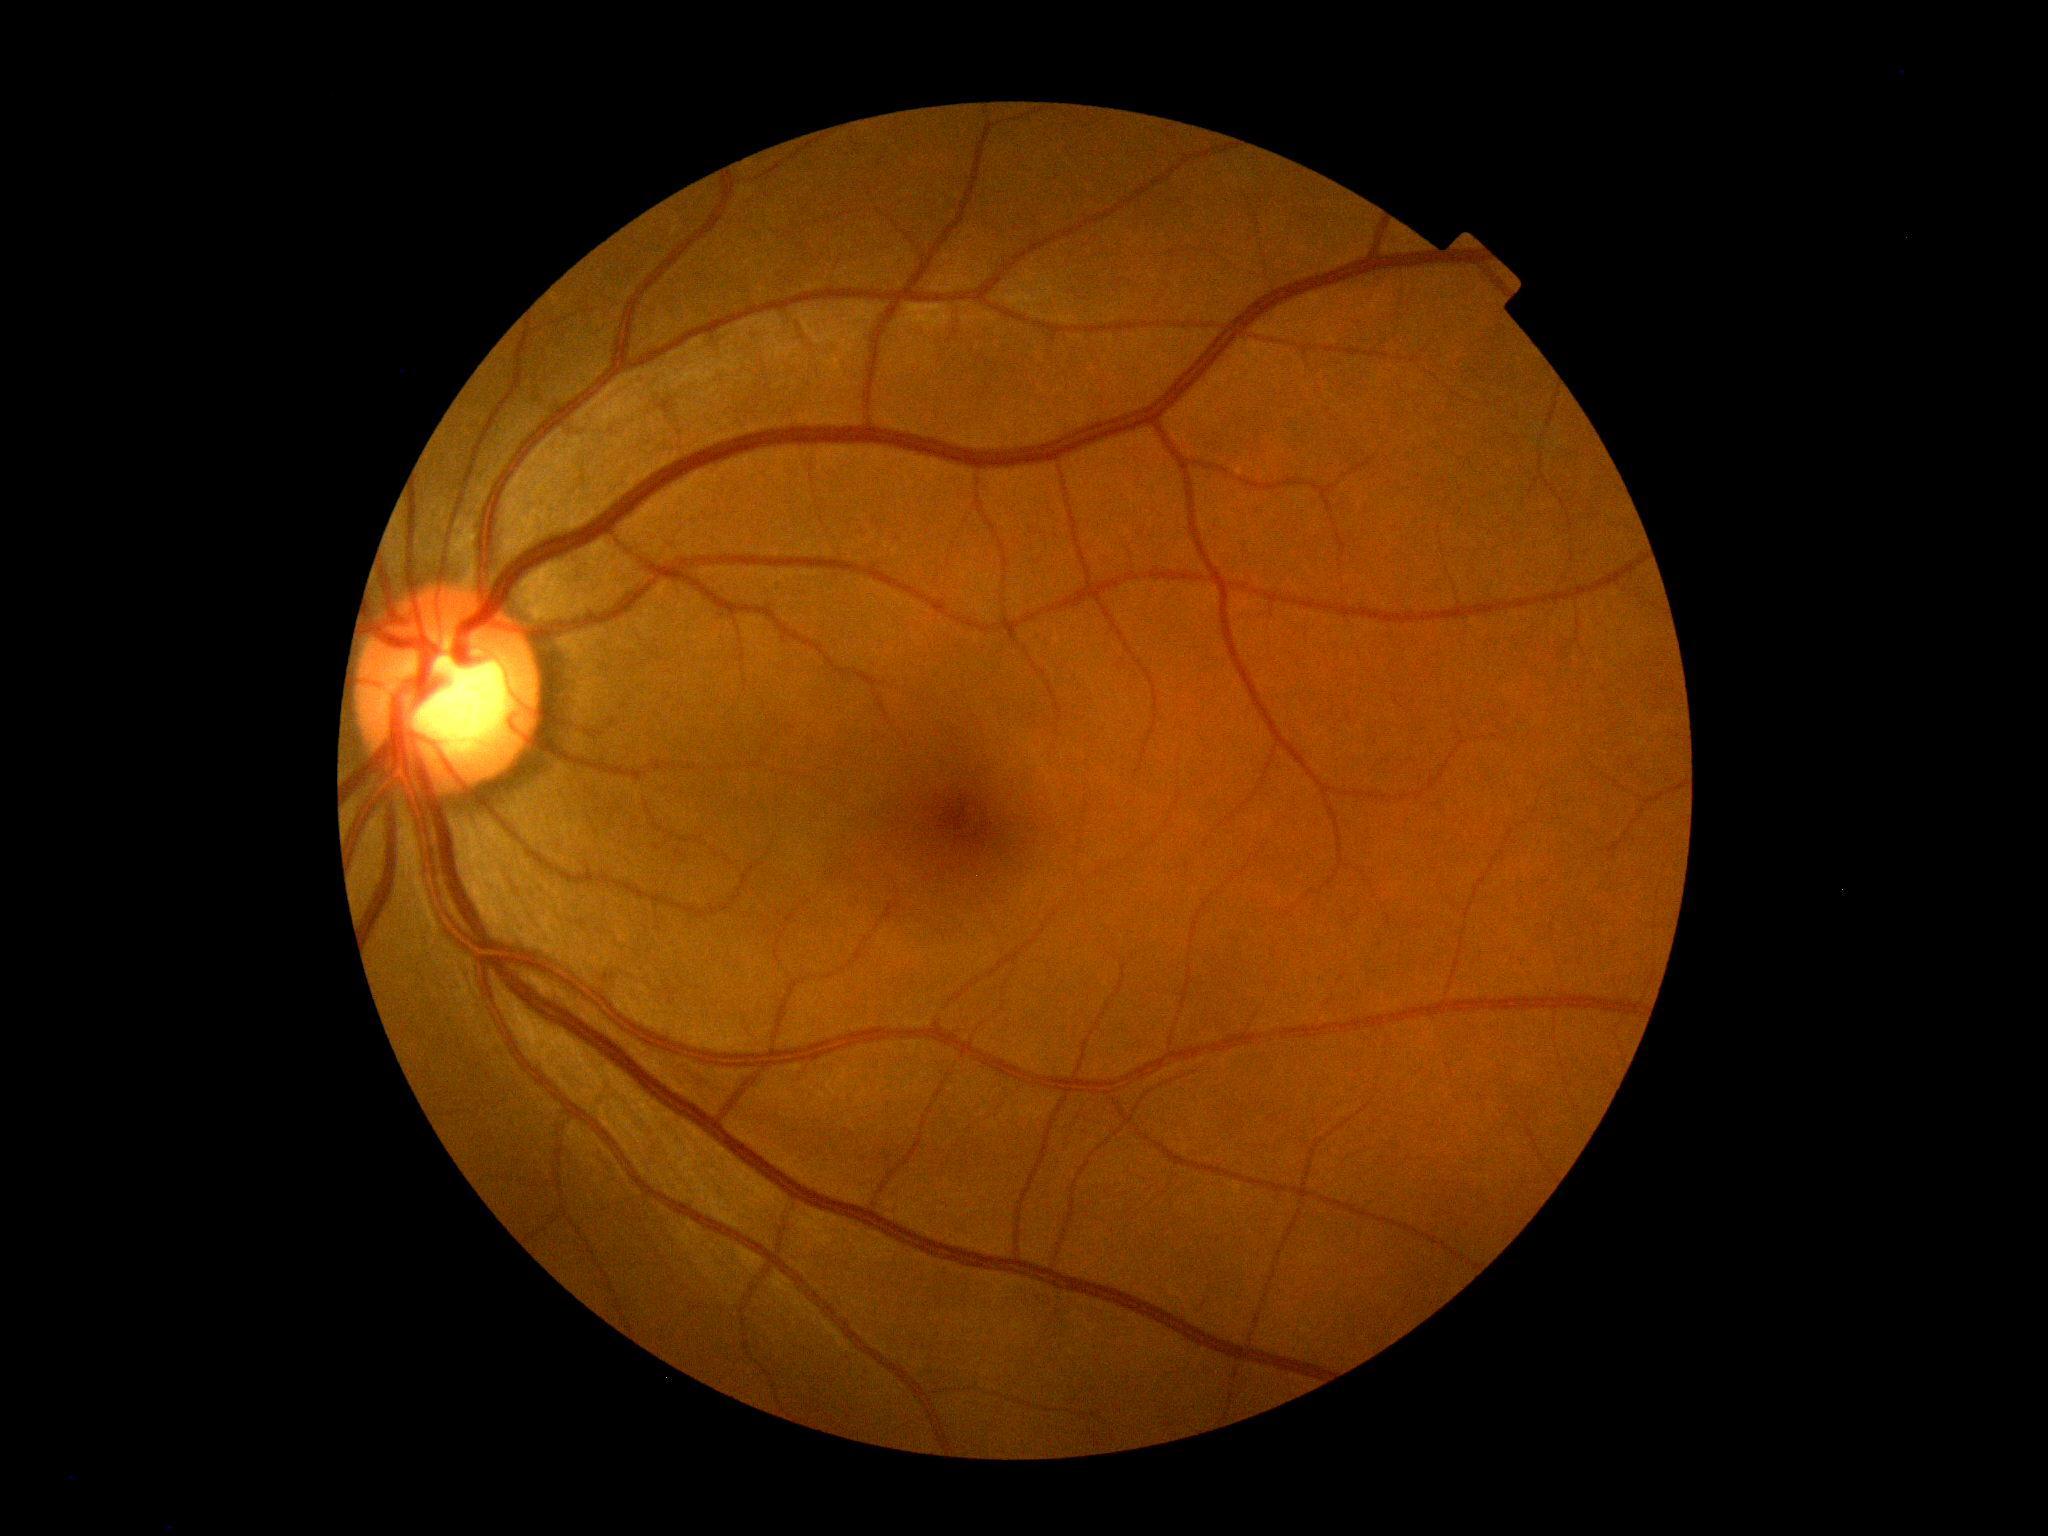
Retinopathy: grade 0 (no apparent retinopathy) — no visible signs of diabetic retinopathy.